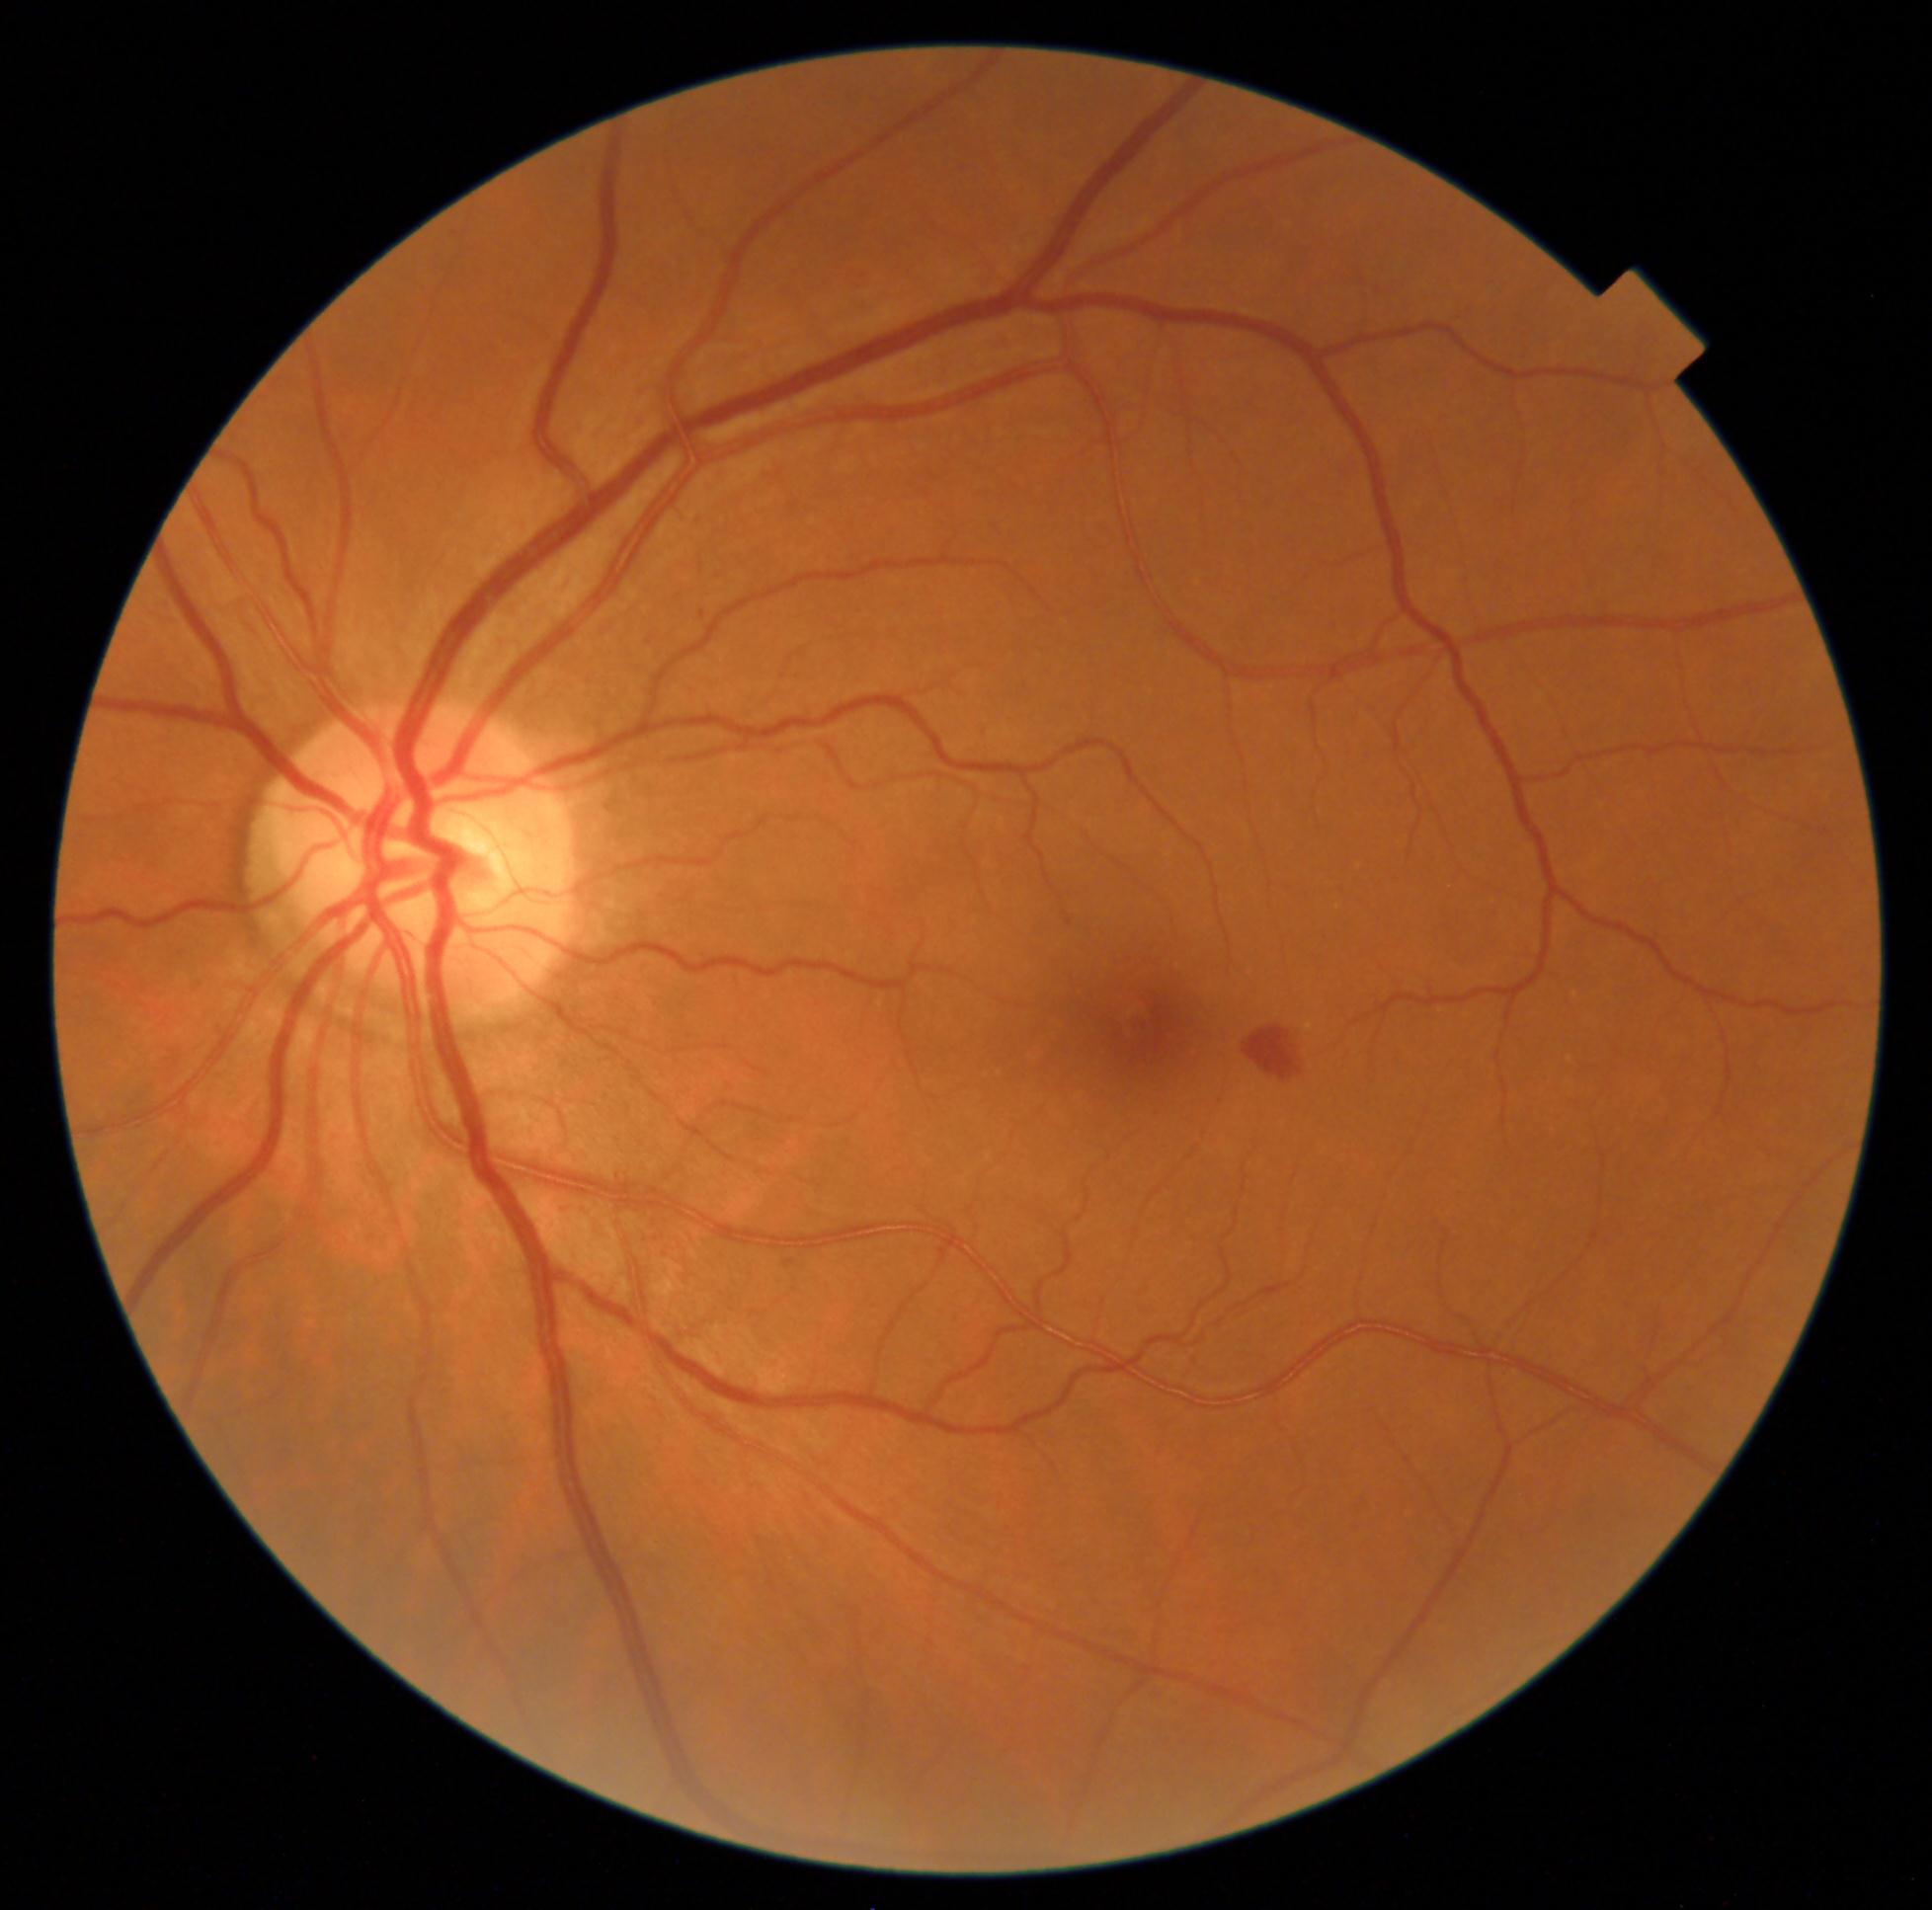

Disease class: non-proliferative diabetic retinopathy. Diabetic retinopathy severity: moderate NPDR (grade 2).